Color fundus photograph, 2100 x 1592 pixels
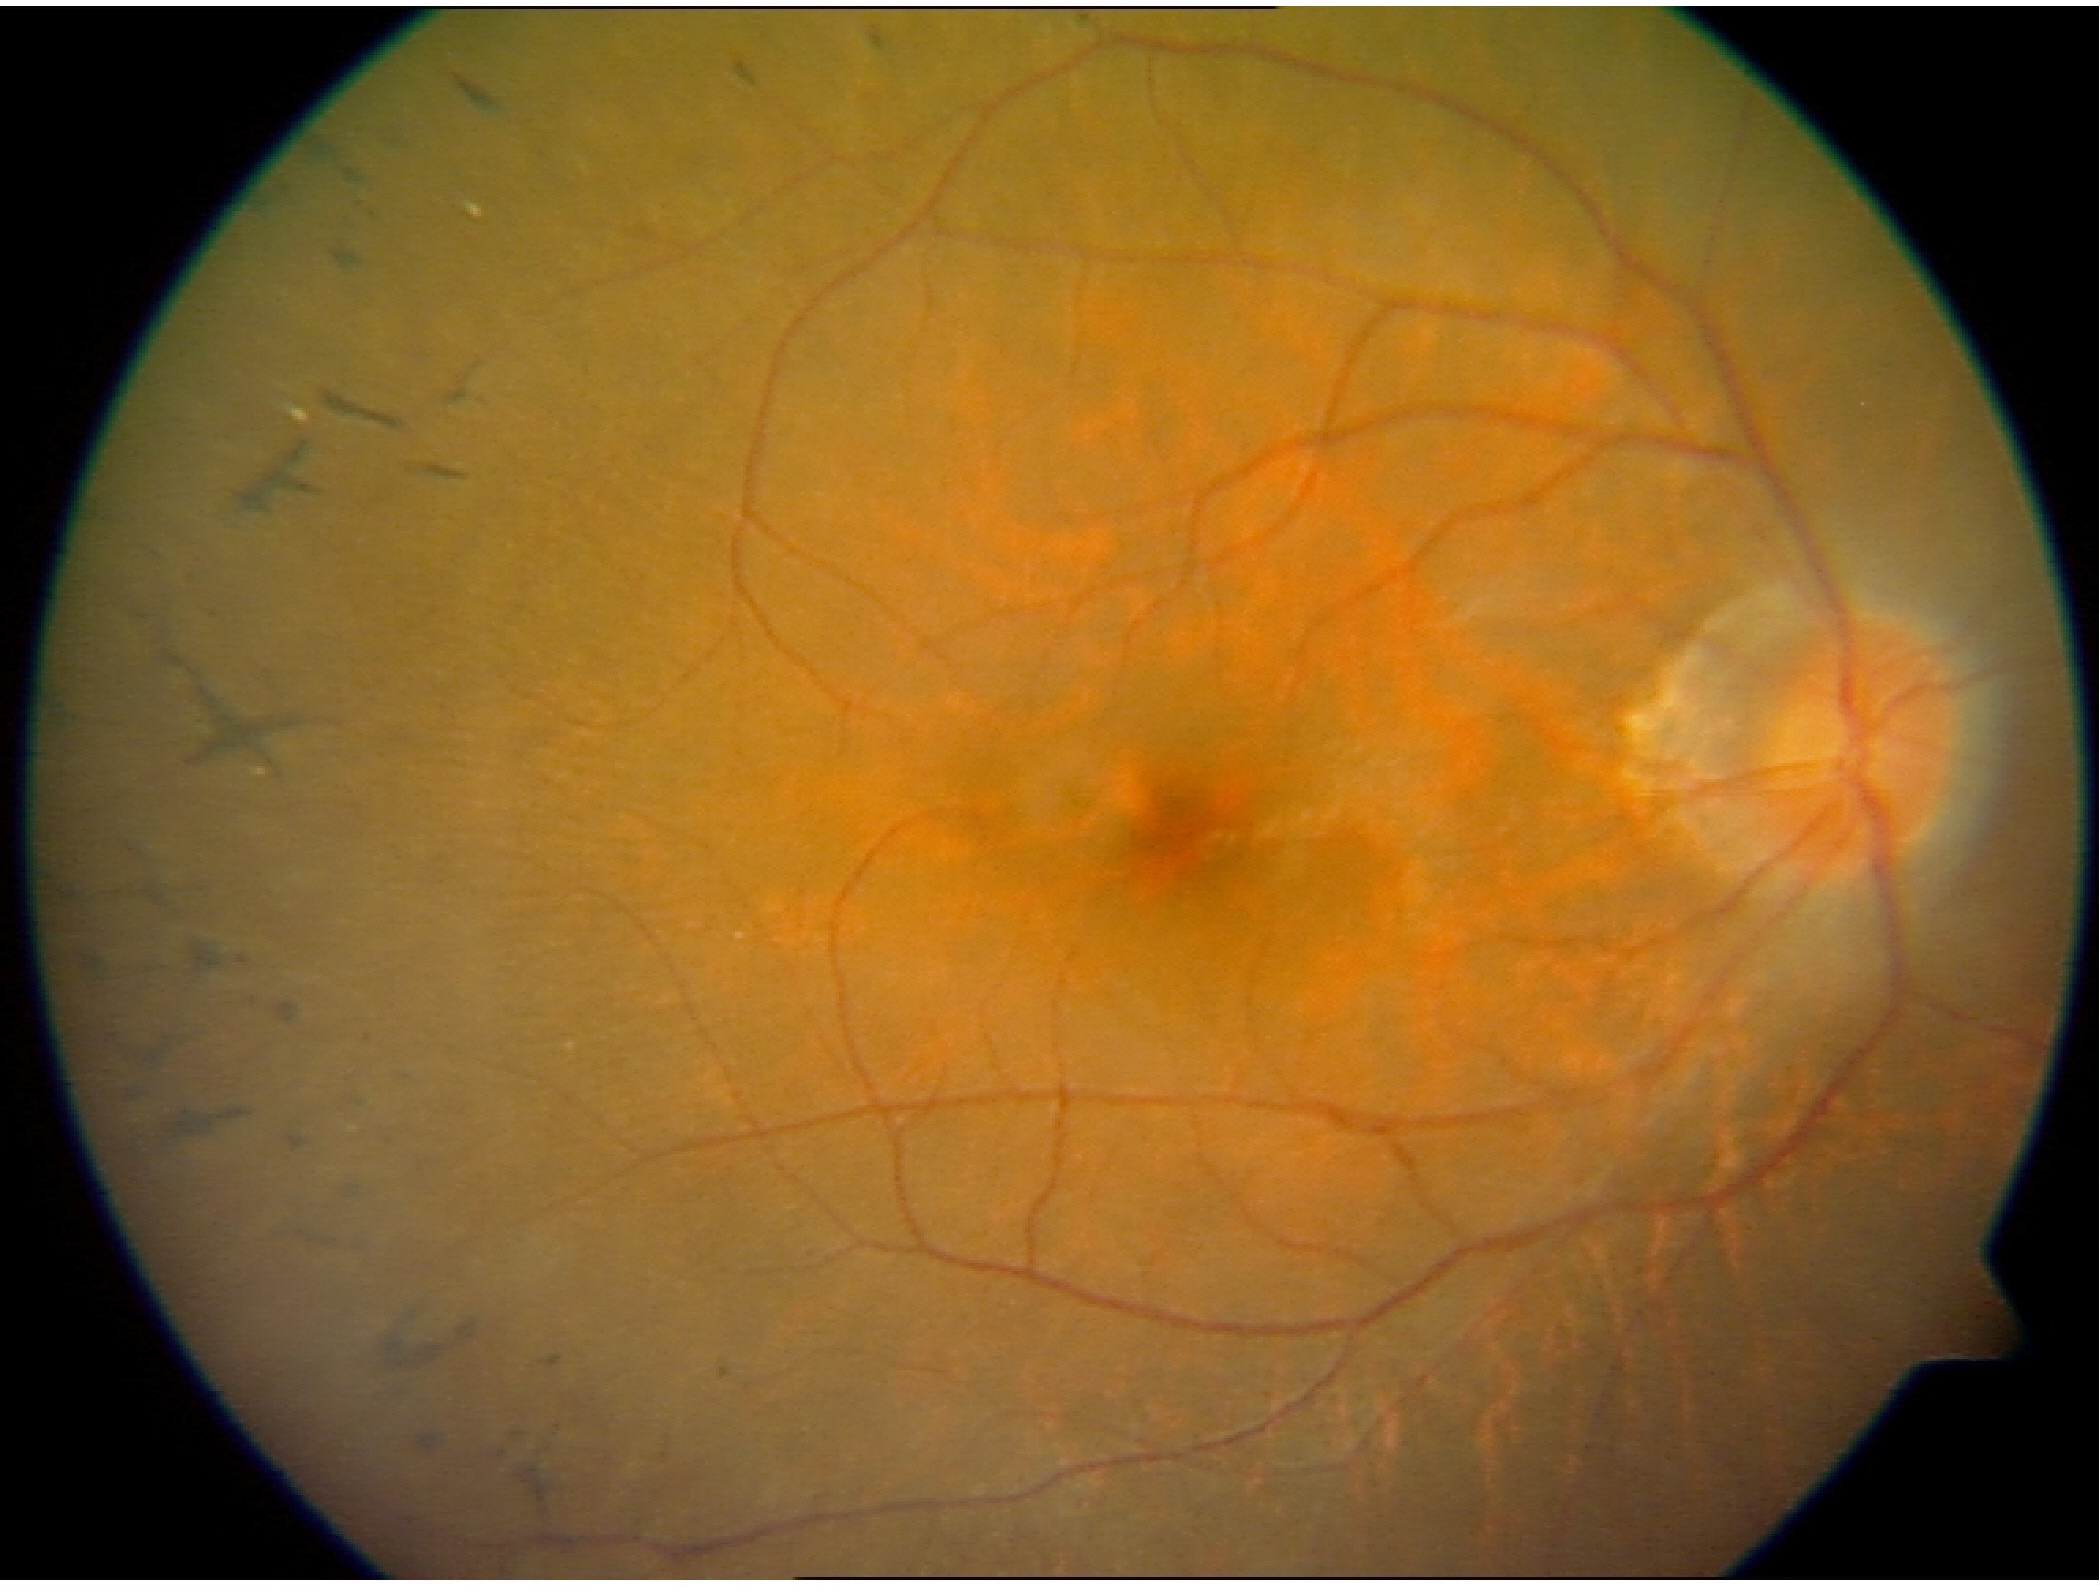

Appearance consistent with retinitis pigmentosa.